Macula-centered:
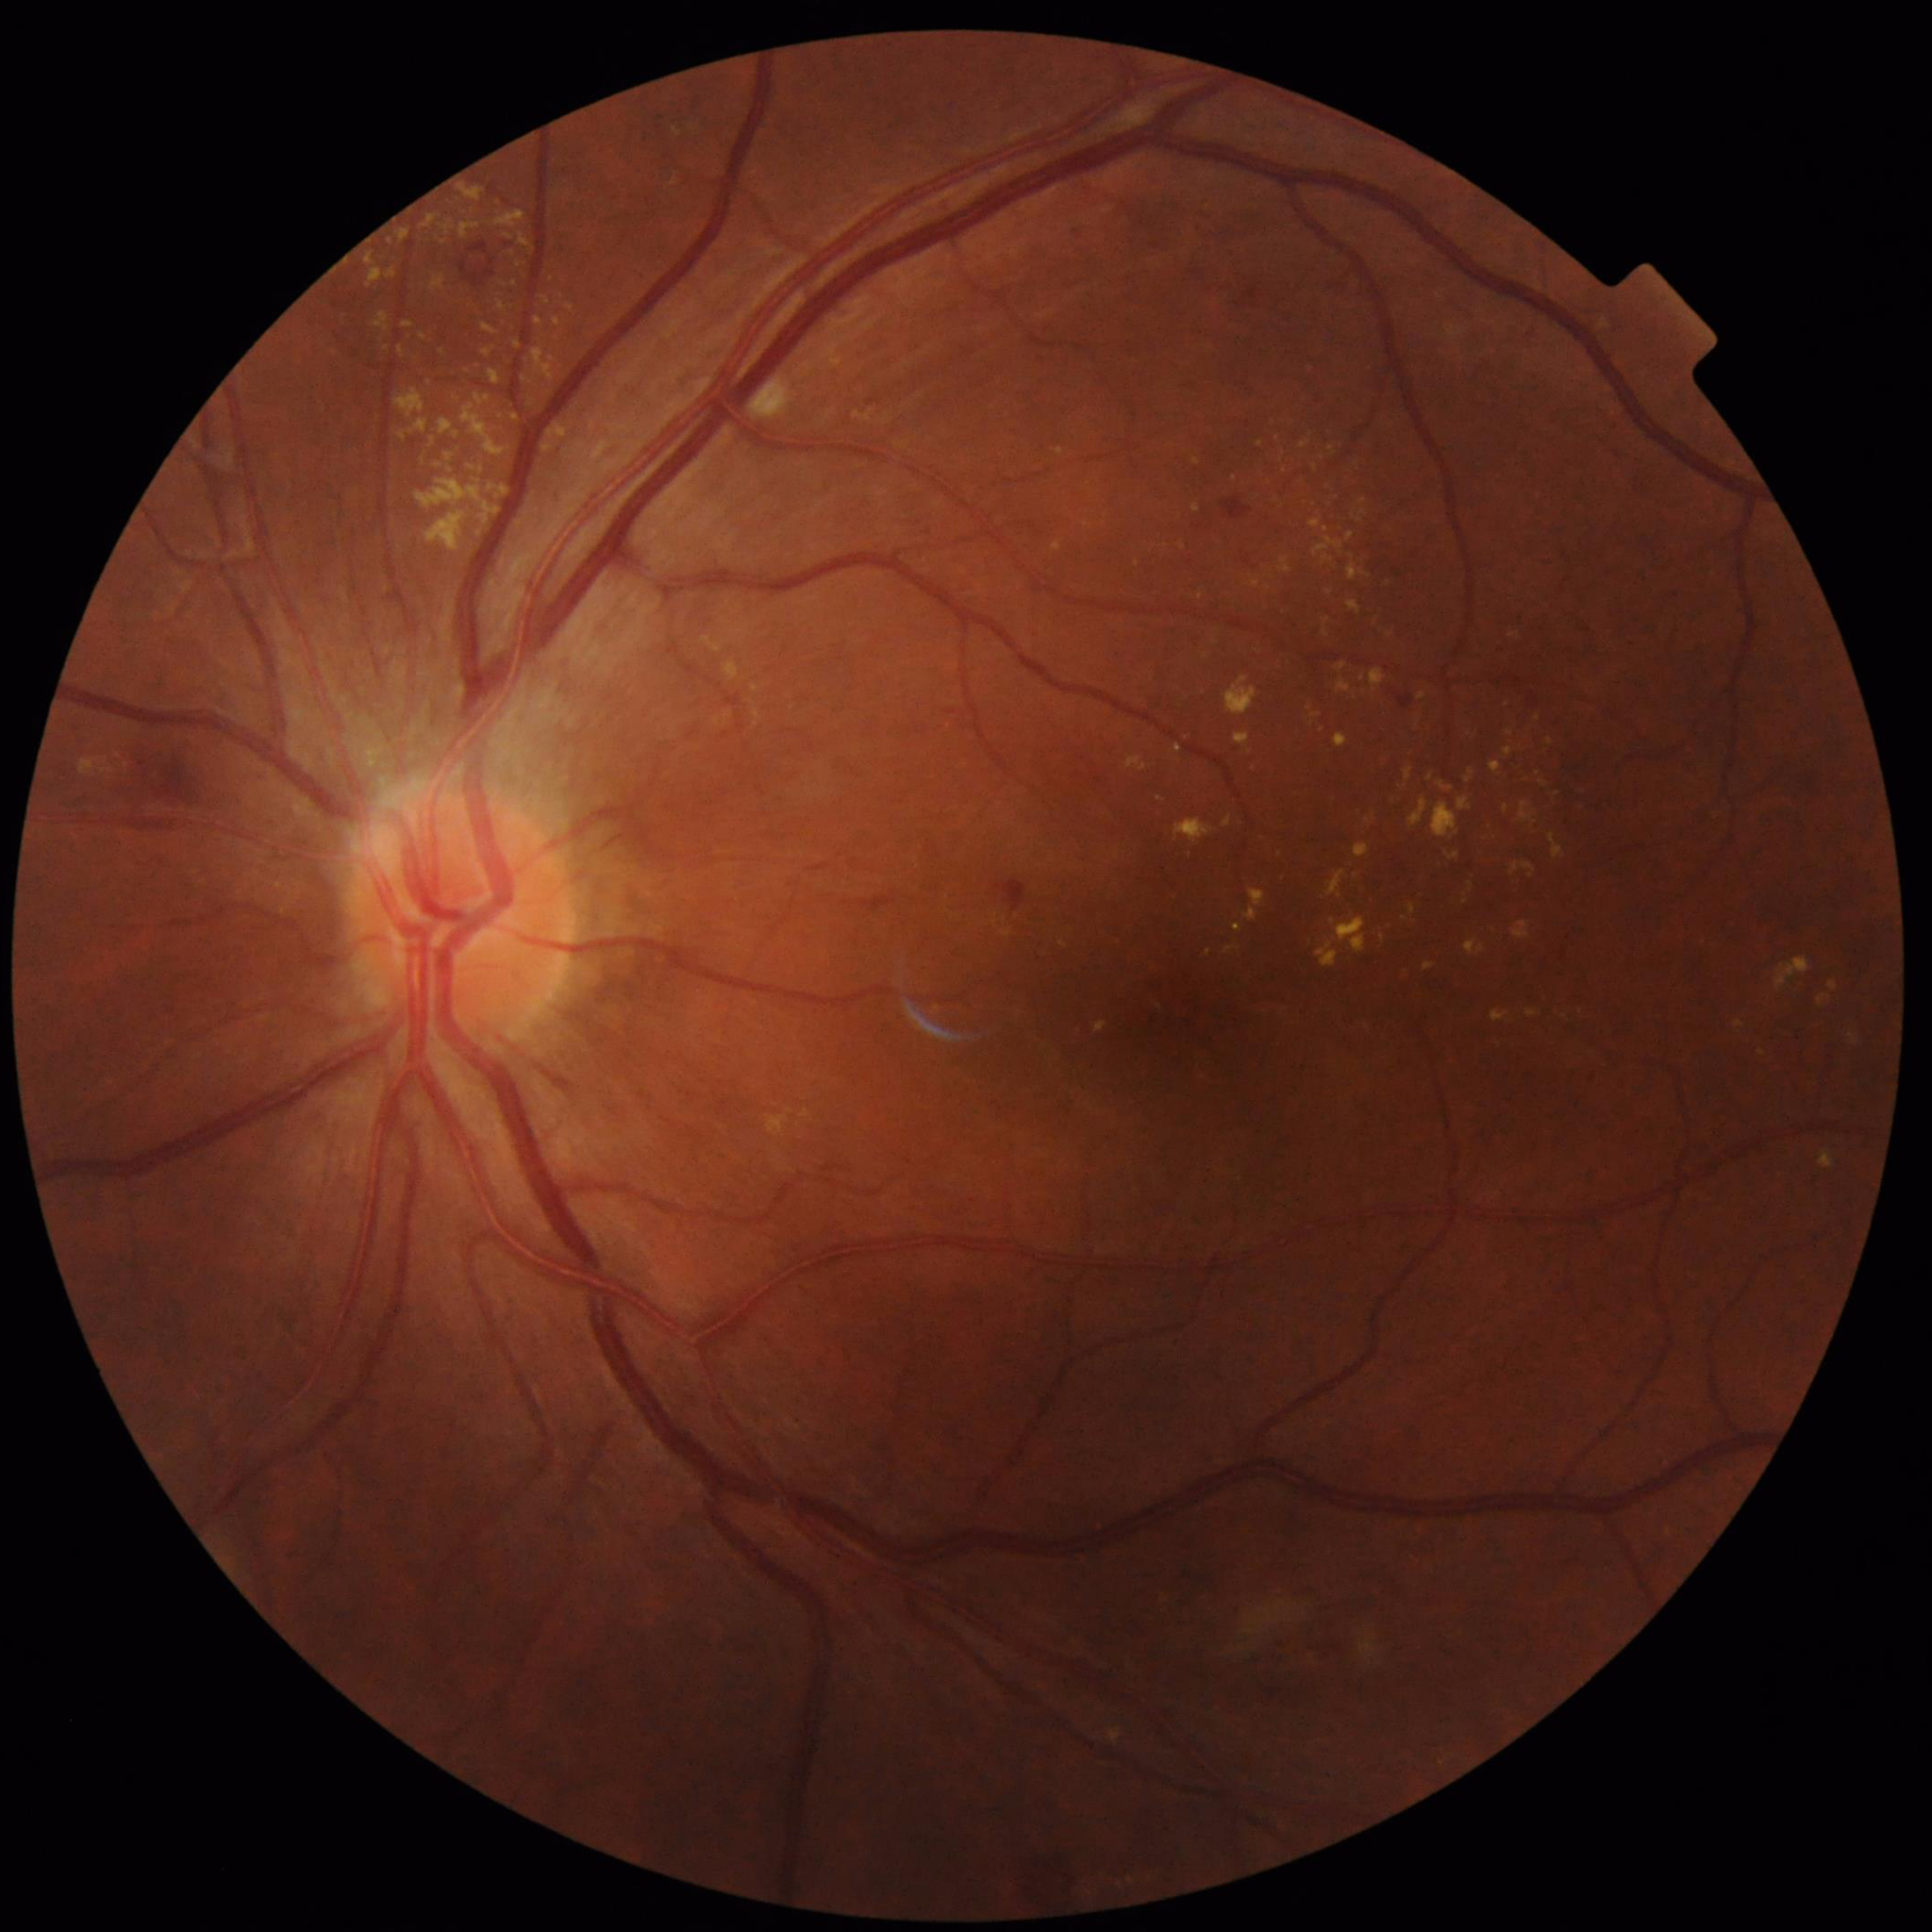 Automated quality assessment = good
Condition = diabetic retinopathy